Wide-field fundus image from infant ROP screening. 1240 x 1240 pixels. Camera: Phoenix ICON (100° FOV): 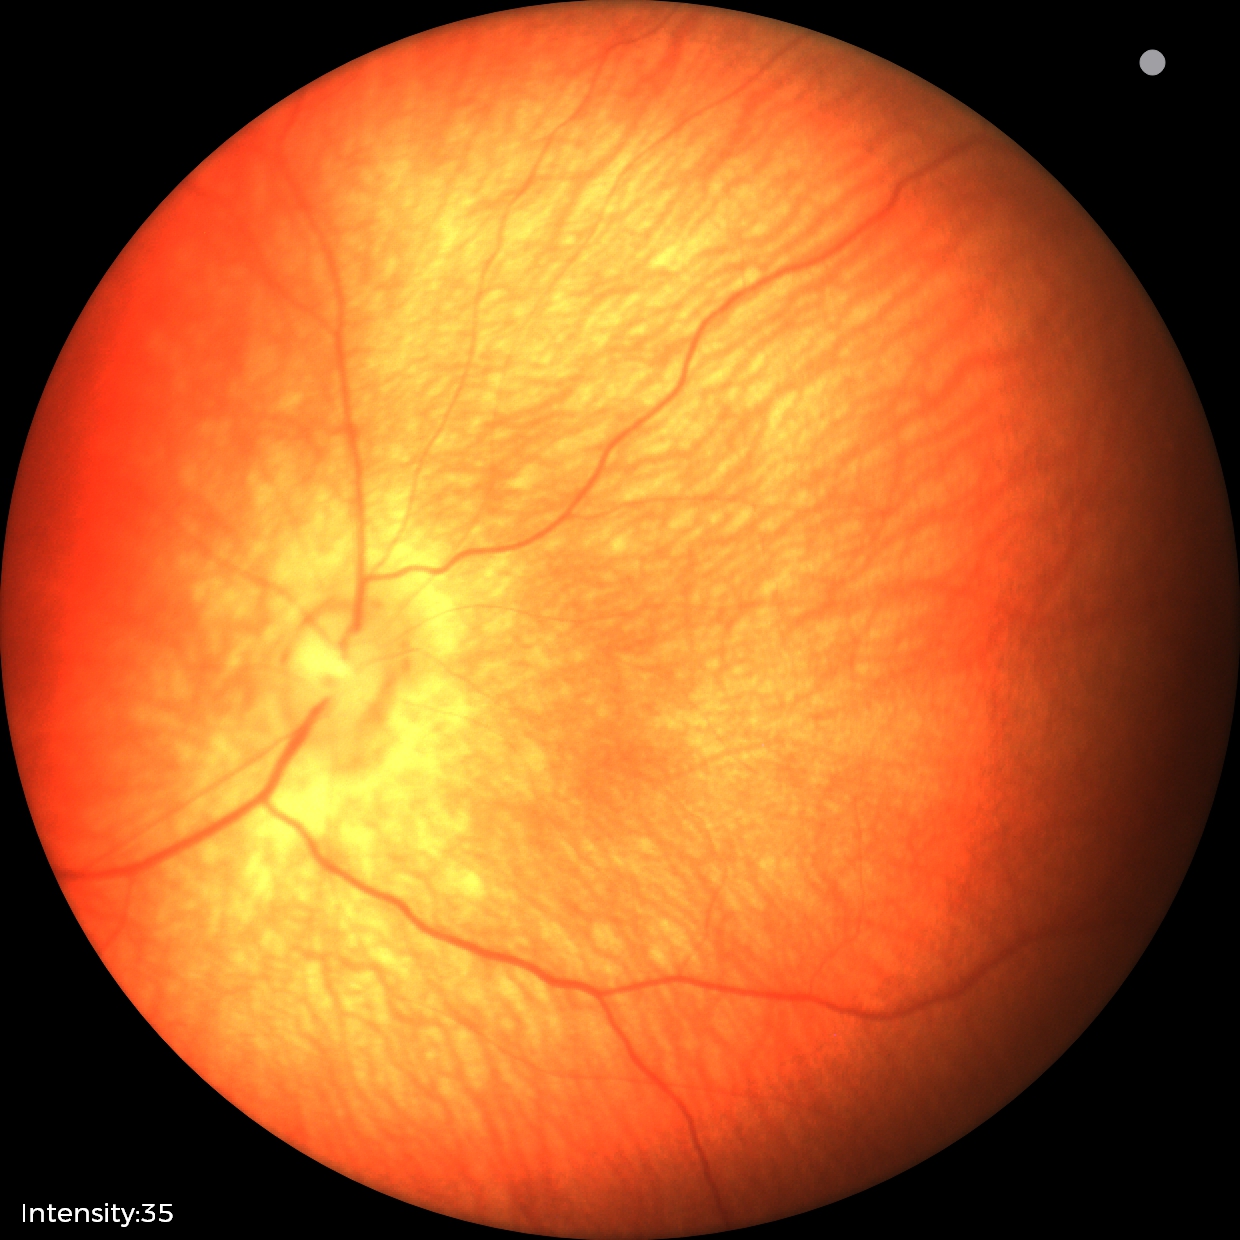

Assessment = physiological appearance.